Color fundus image, 1659x2212px — 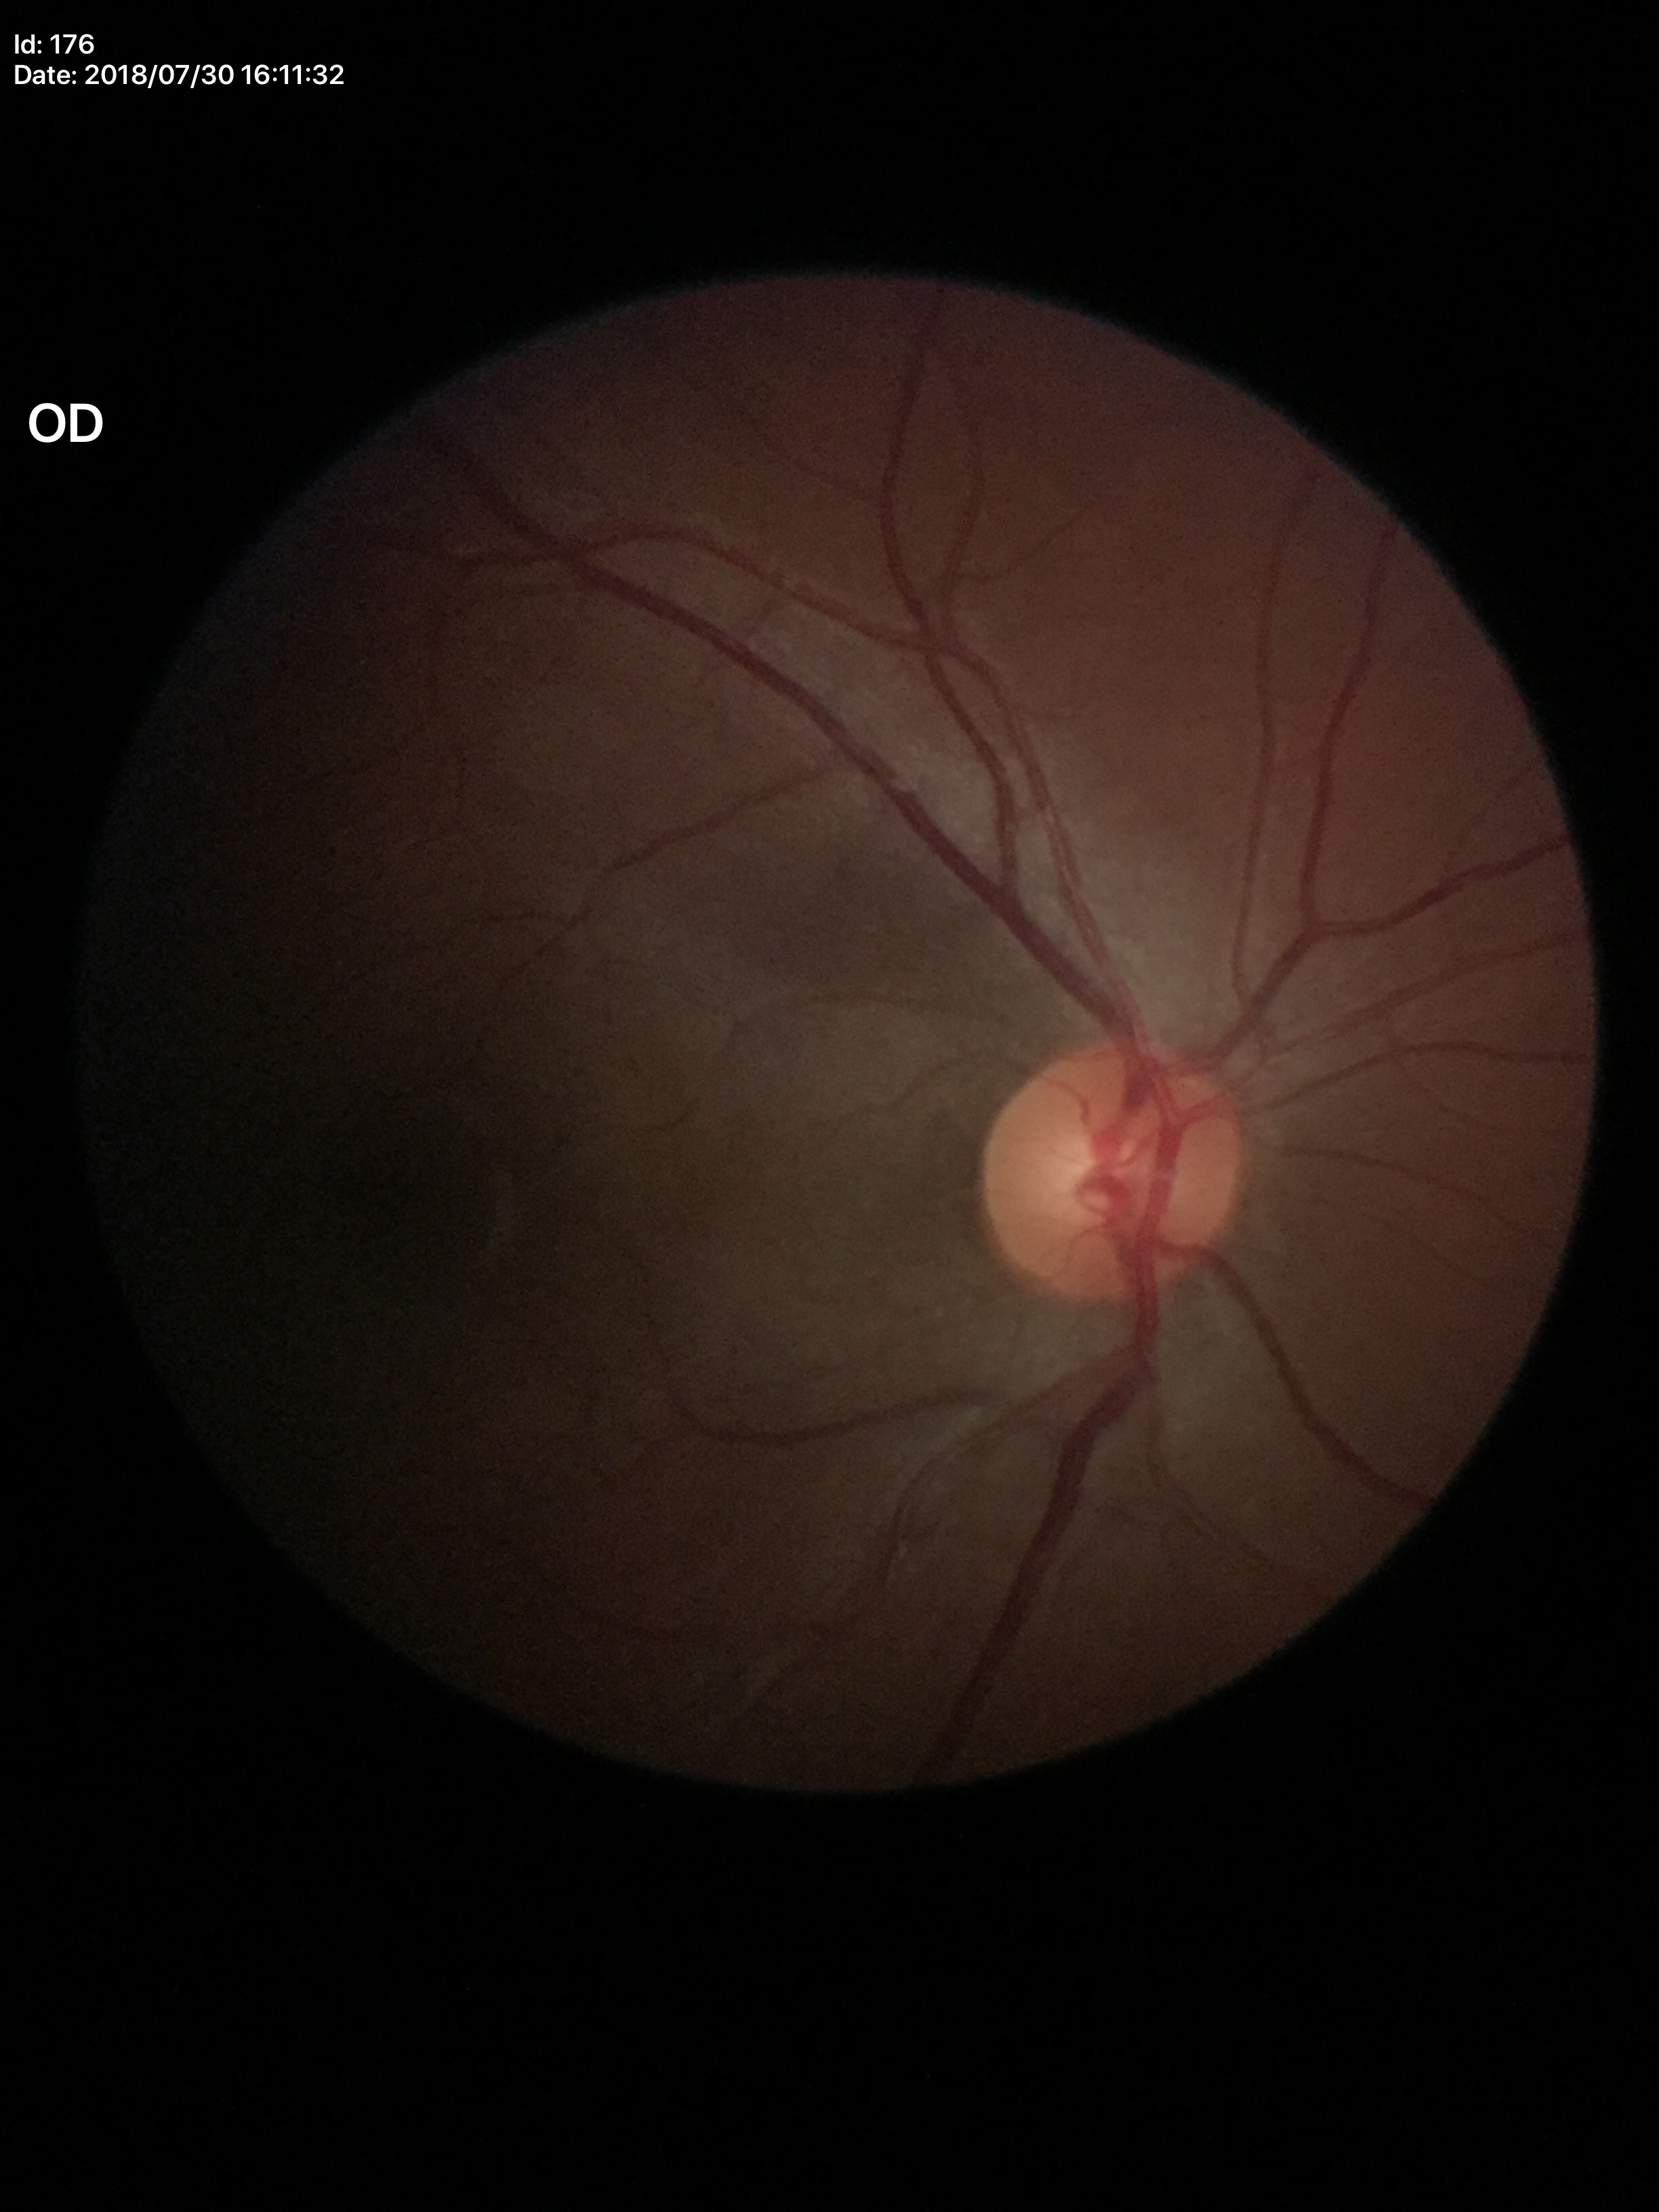
{
  "glaucoma_decision": "not suspect (1/5 graders called glaucoma suspect)",
  "vcdr": "0.52"
}